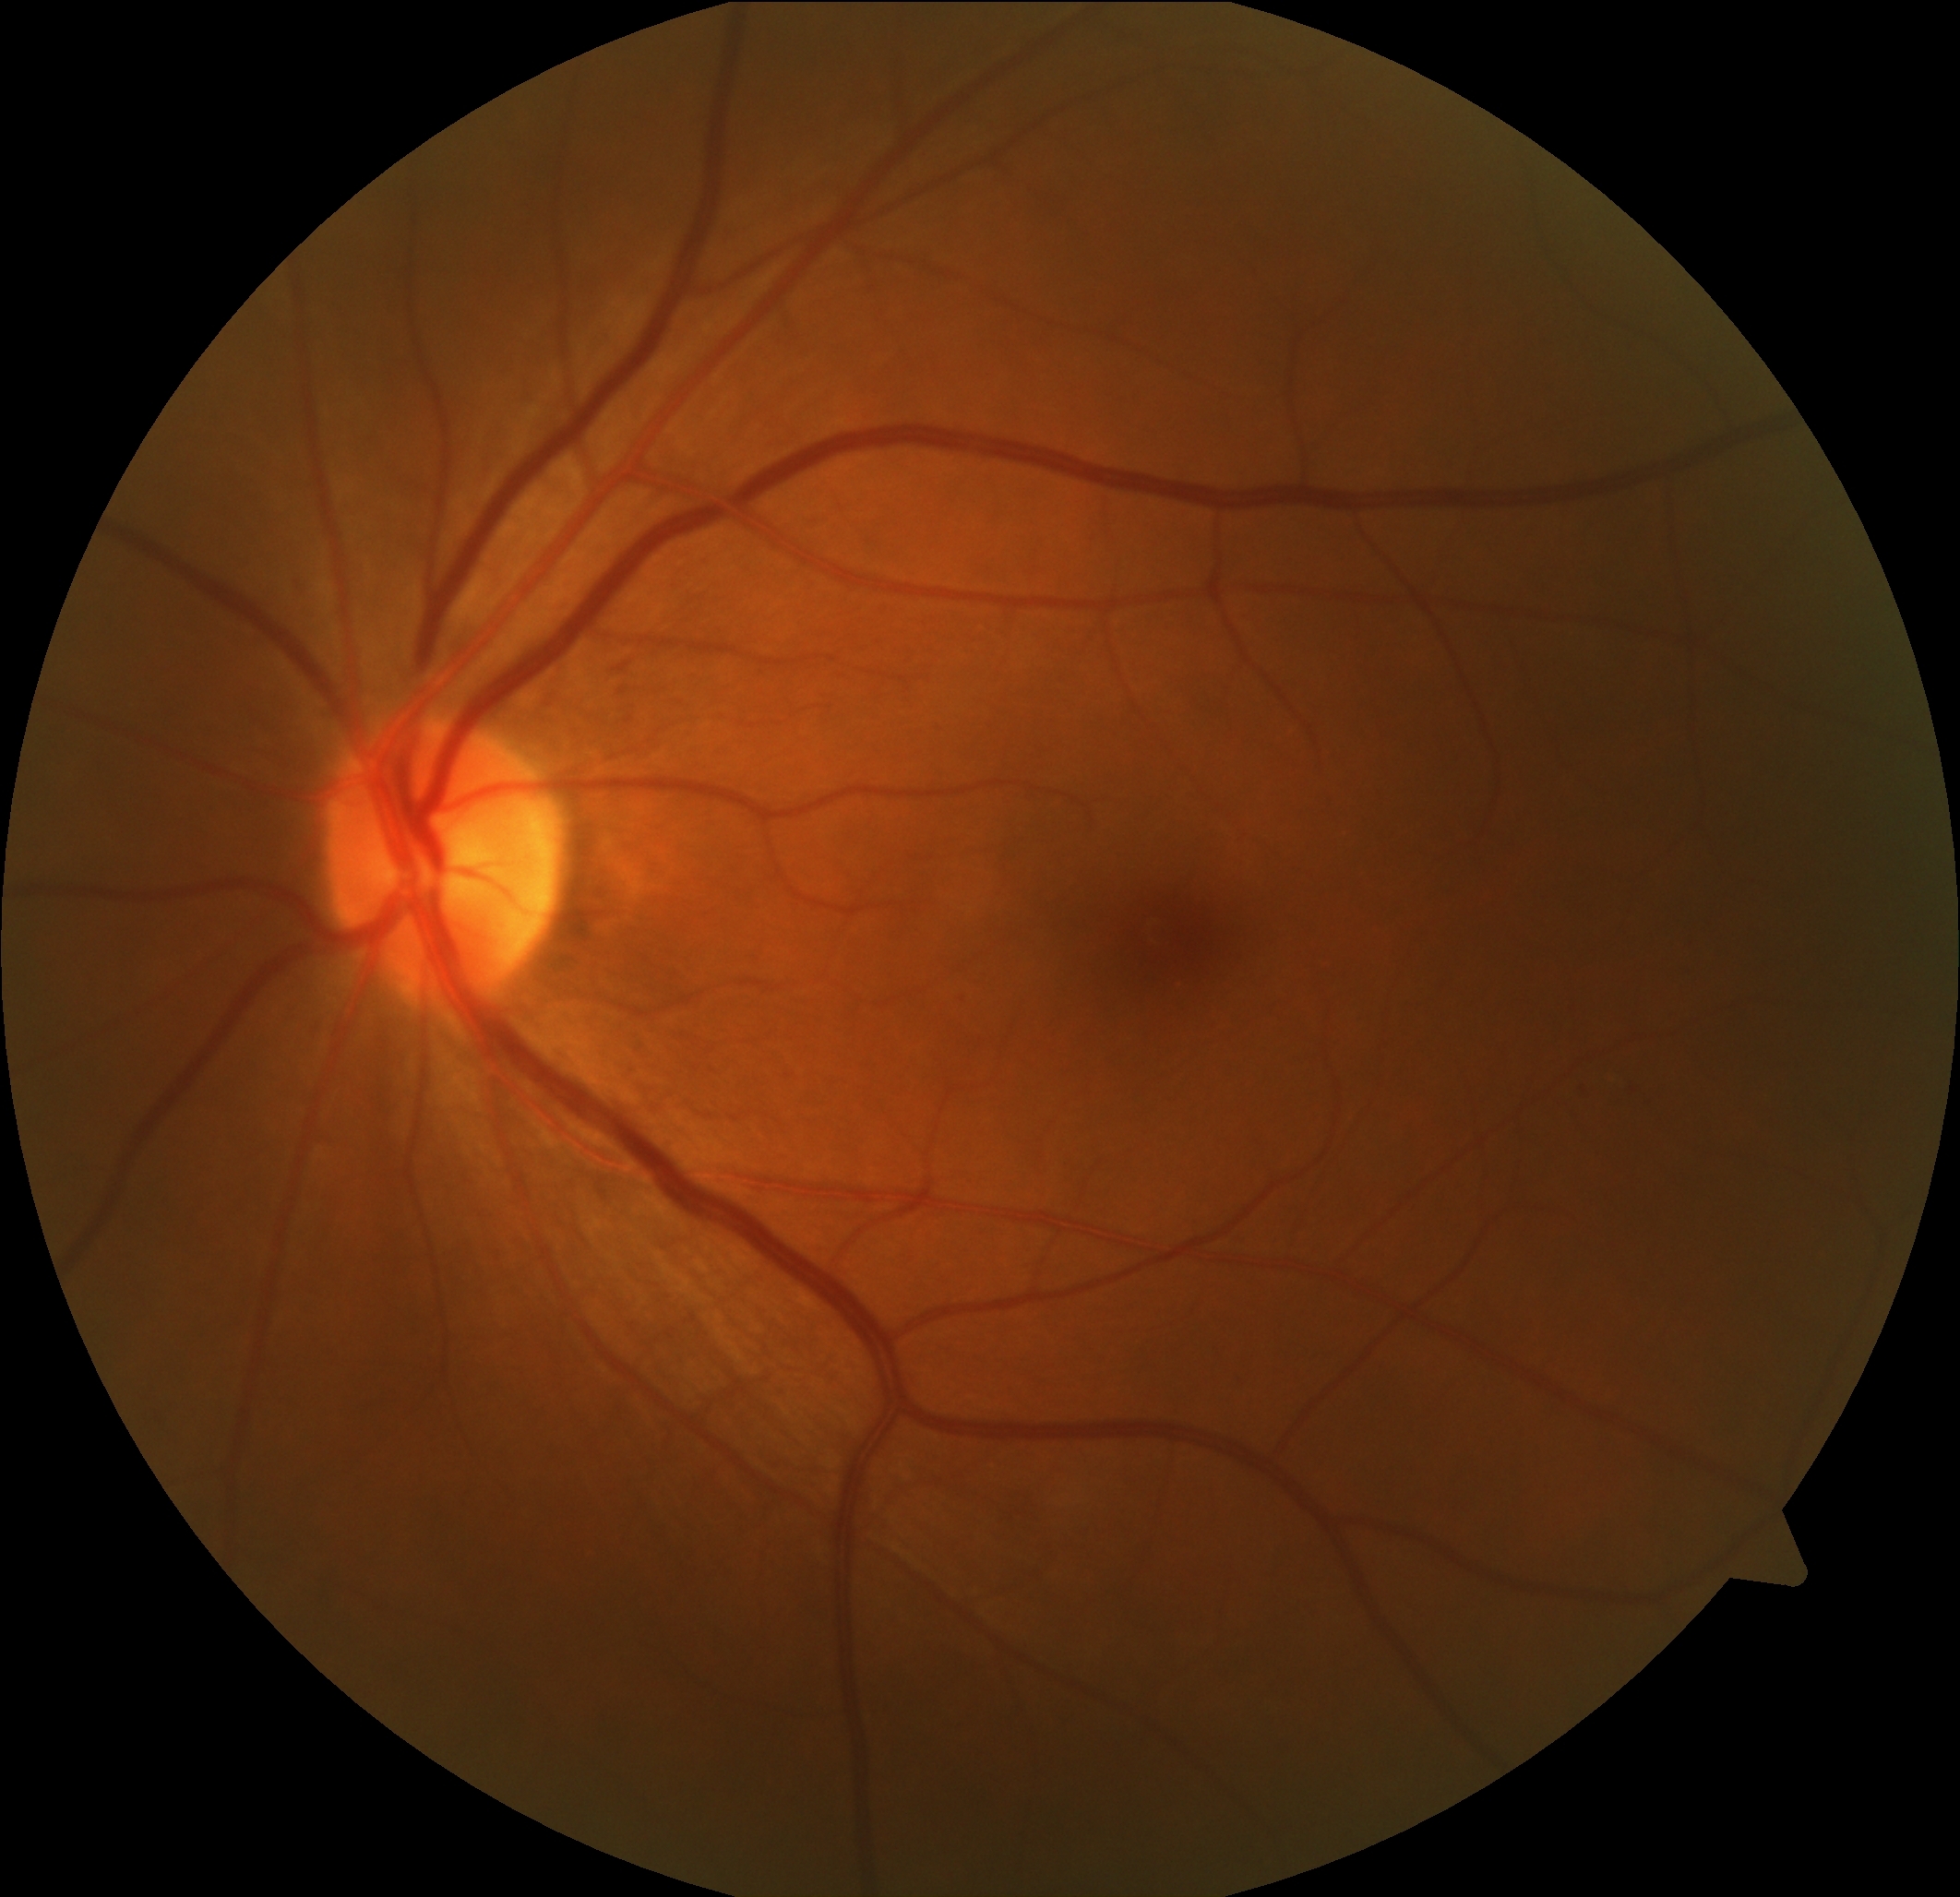 DR is mild non-proliferative diabetic retinopathy (grade 1) — presence of microaneurysms only. DR class: non-proliferative diabetic retinopathy.